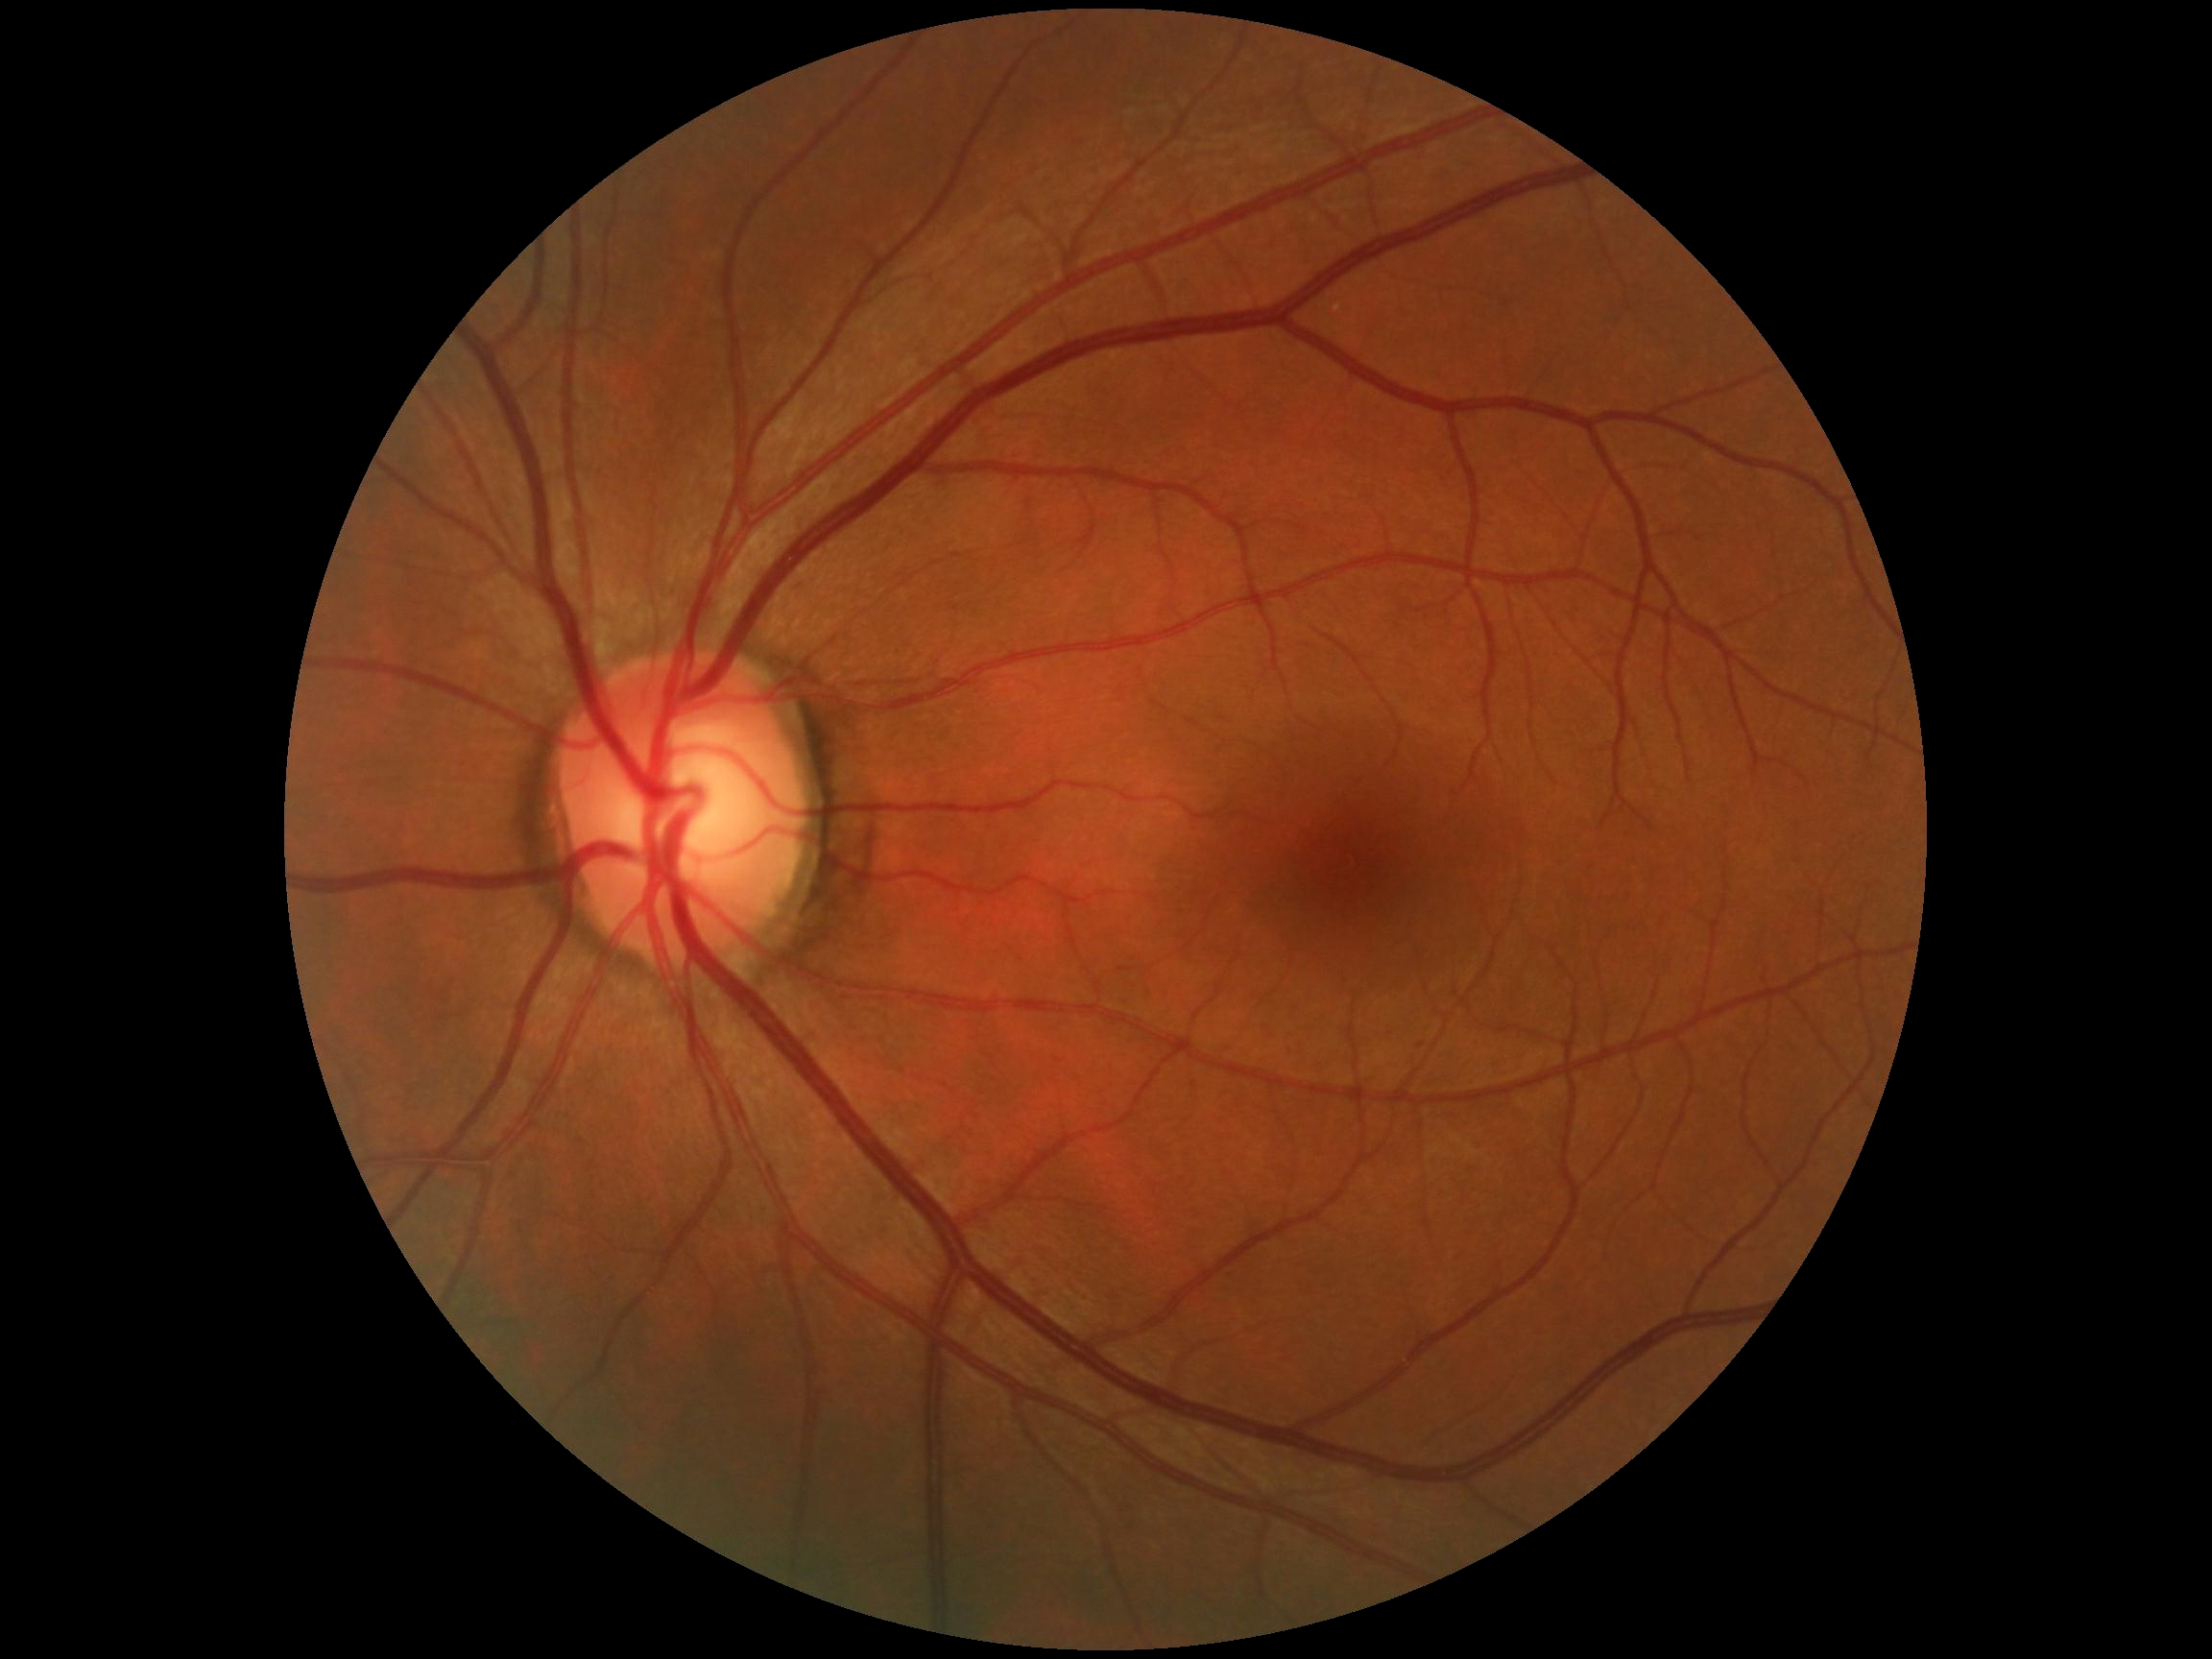 No signs of diabetic retinopathy.
Diabetic retinopathy (DR) is no apparent diabetic retinopathy (grade 0).